Infant wide-field retinal image · image size 640x480:
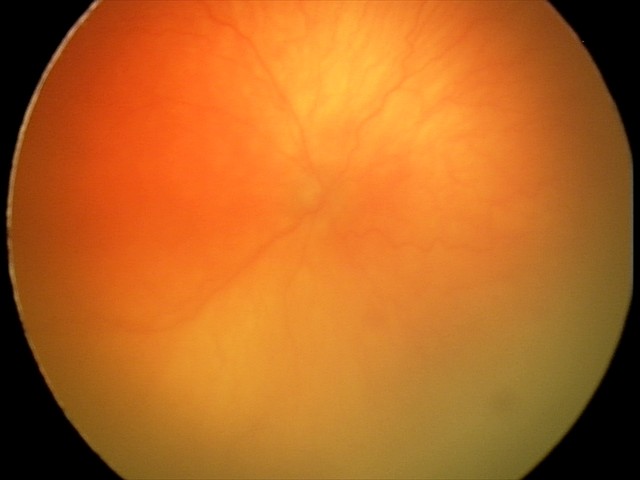
From an examination with diagnosis of aggressive retinopathy of prematurity (A-ROP).